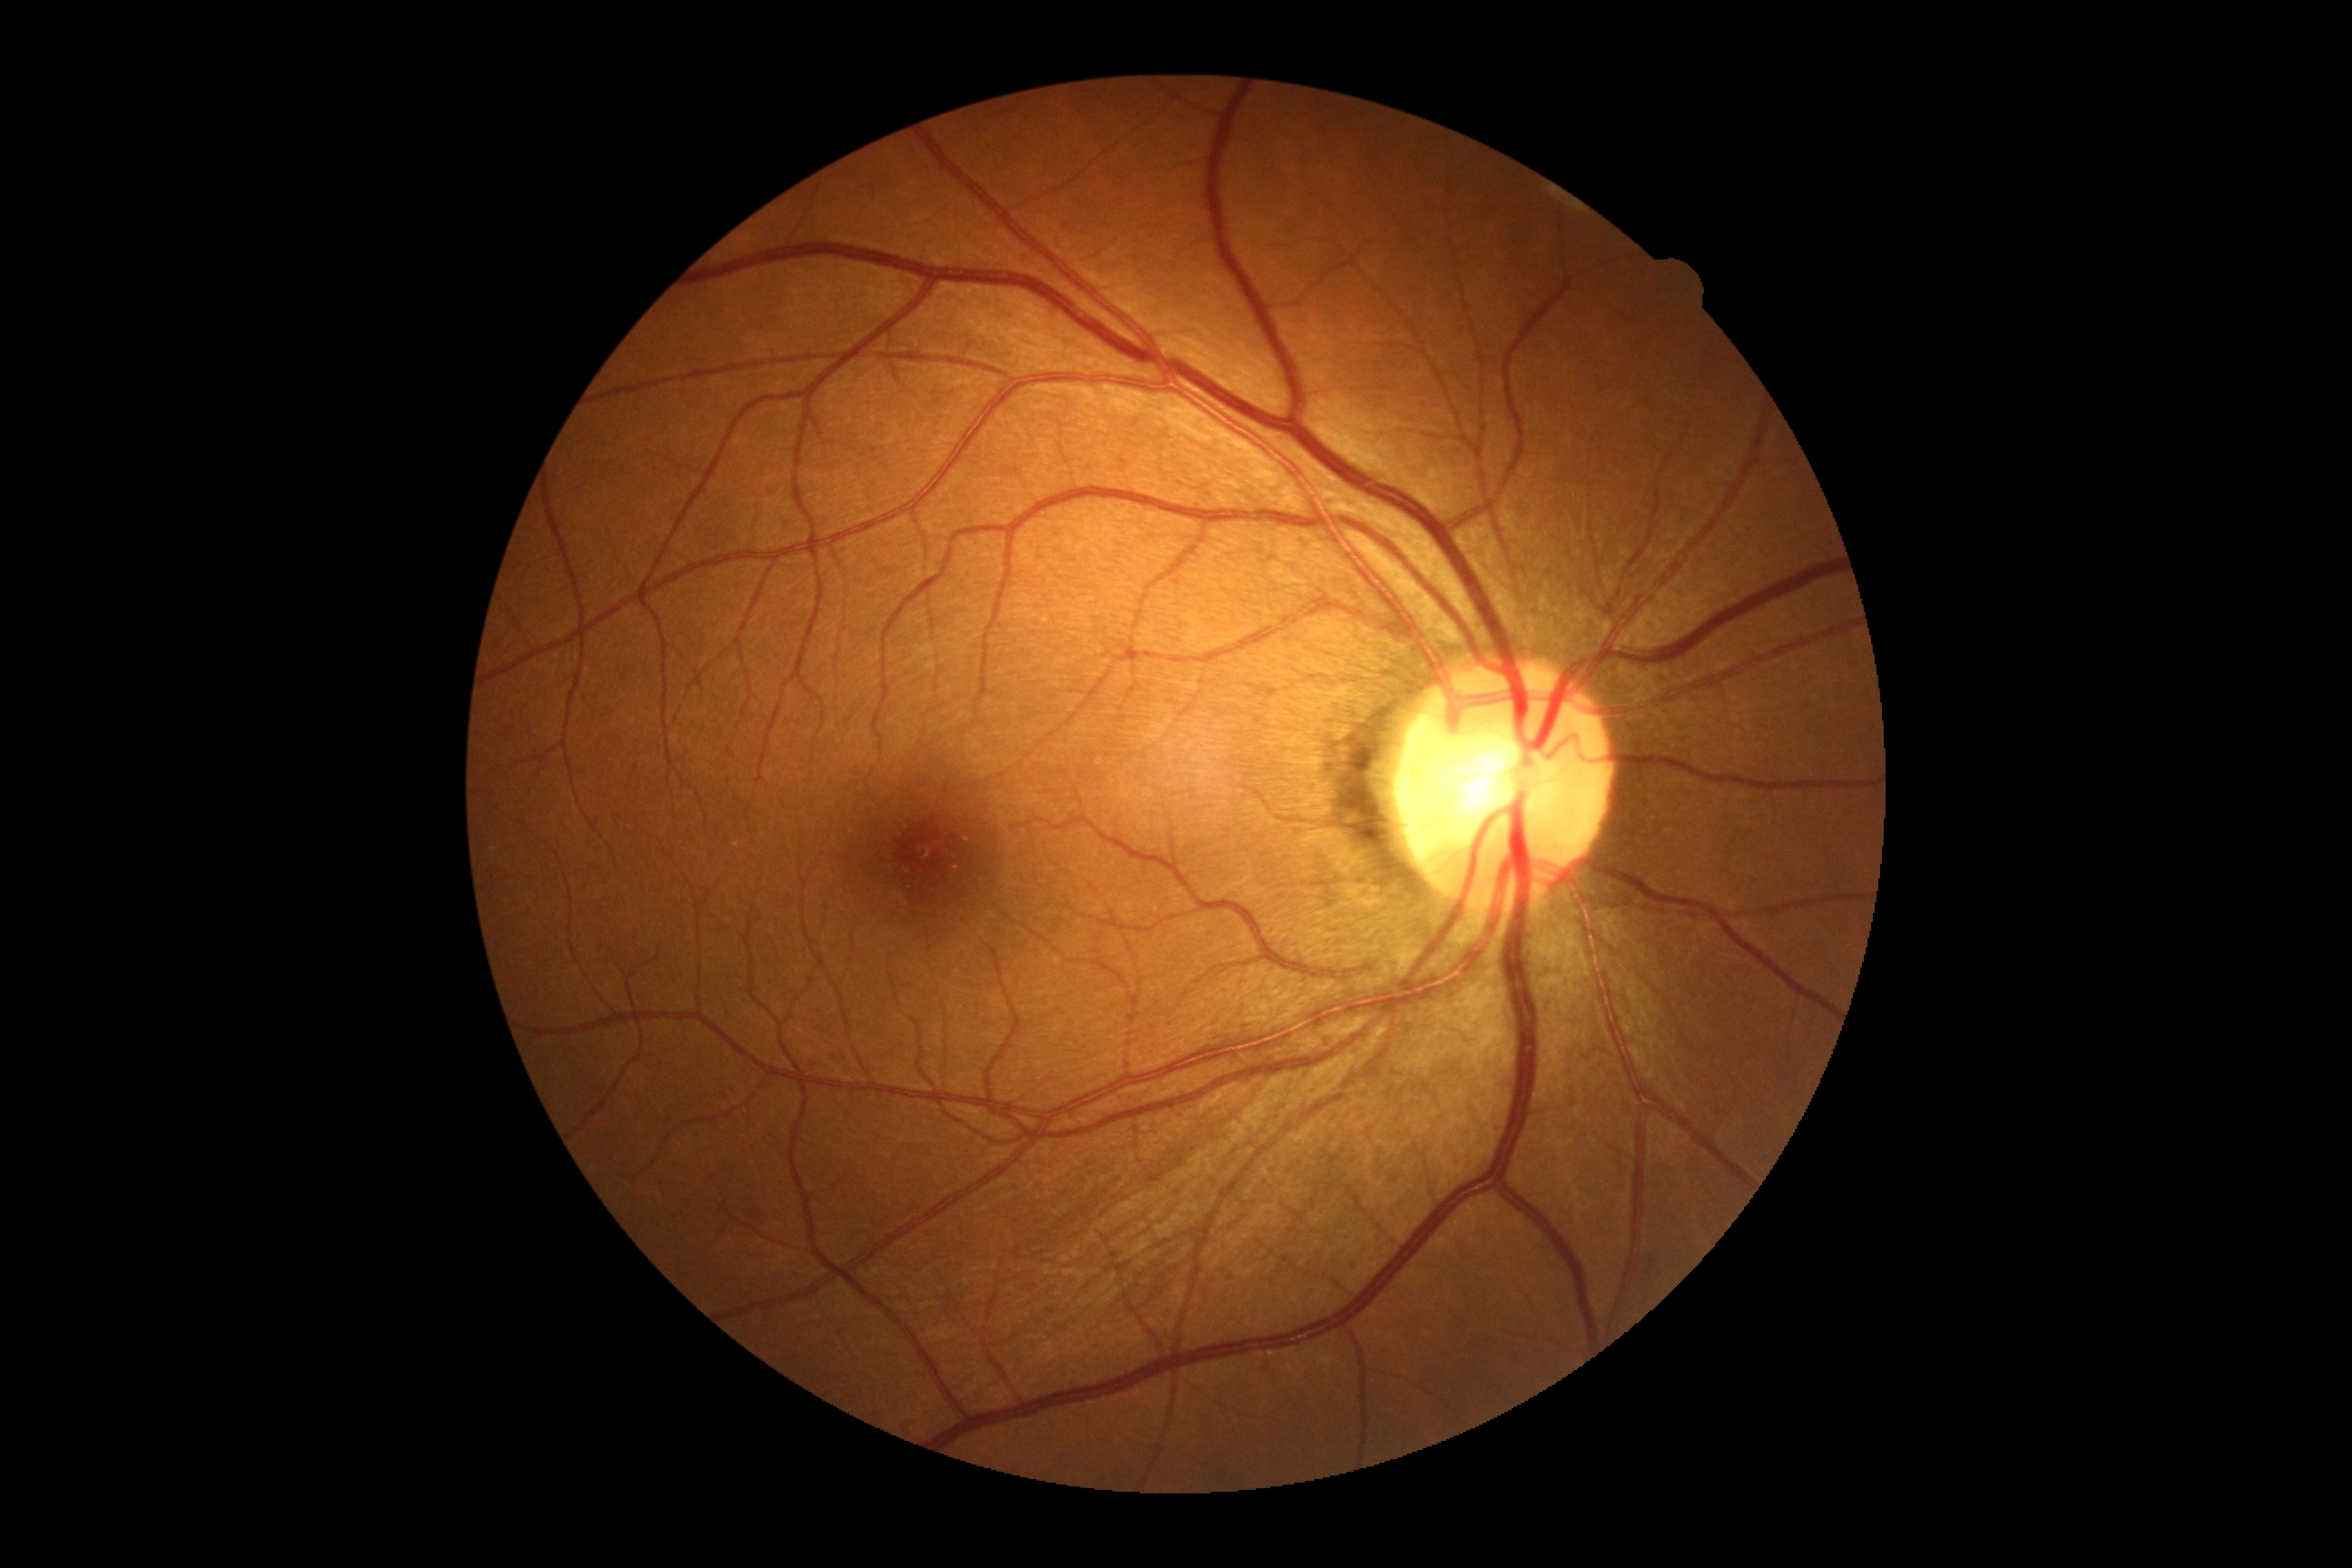 No diabetic retinal disease findings. DR stage is no apparent retinopathy (grade 0) — no visible signs of diabetic retinopathy.